Pediatric wide-field fundus photograph: 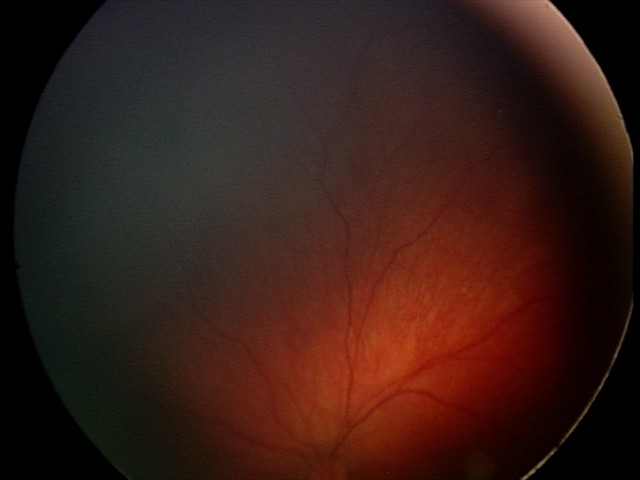
Screening examination consistent with retinal hemorrhages.